CFP
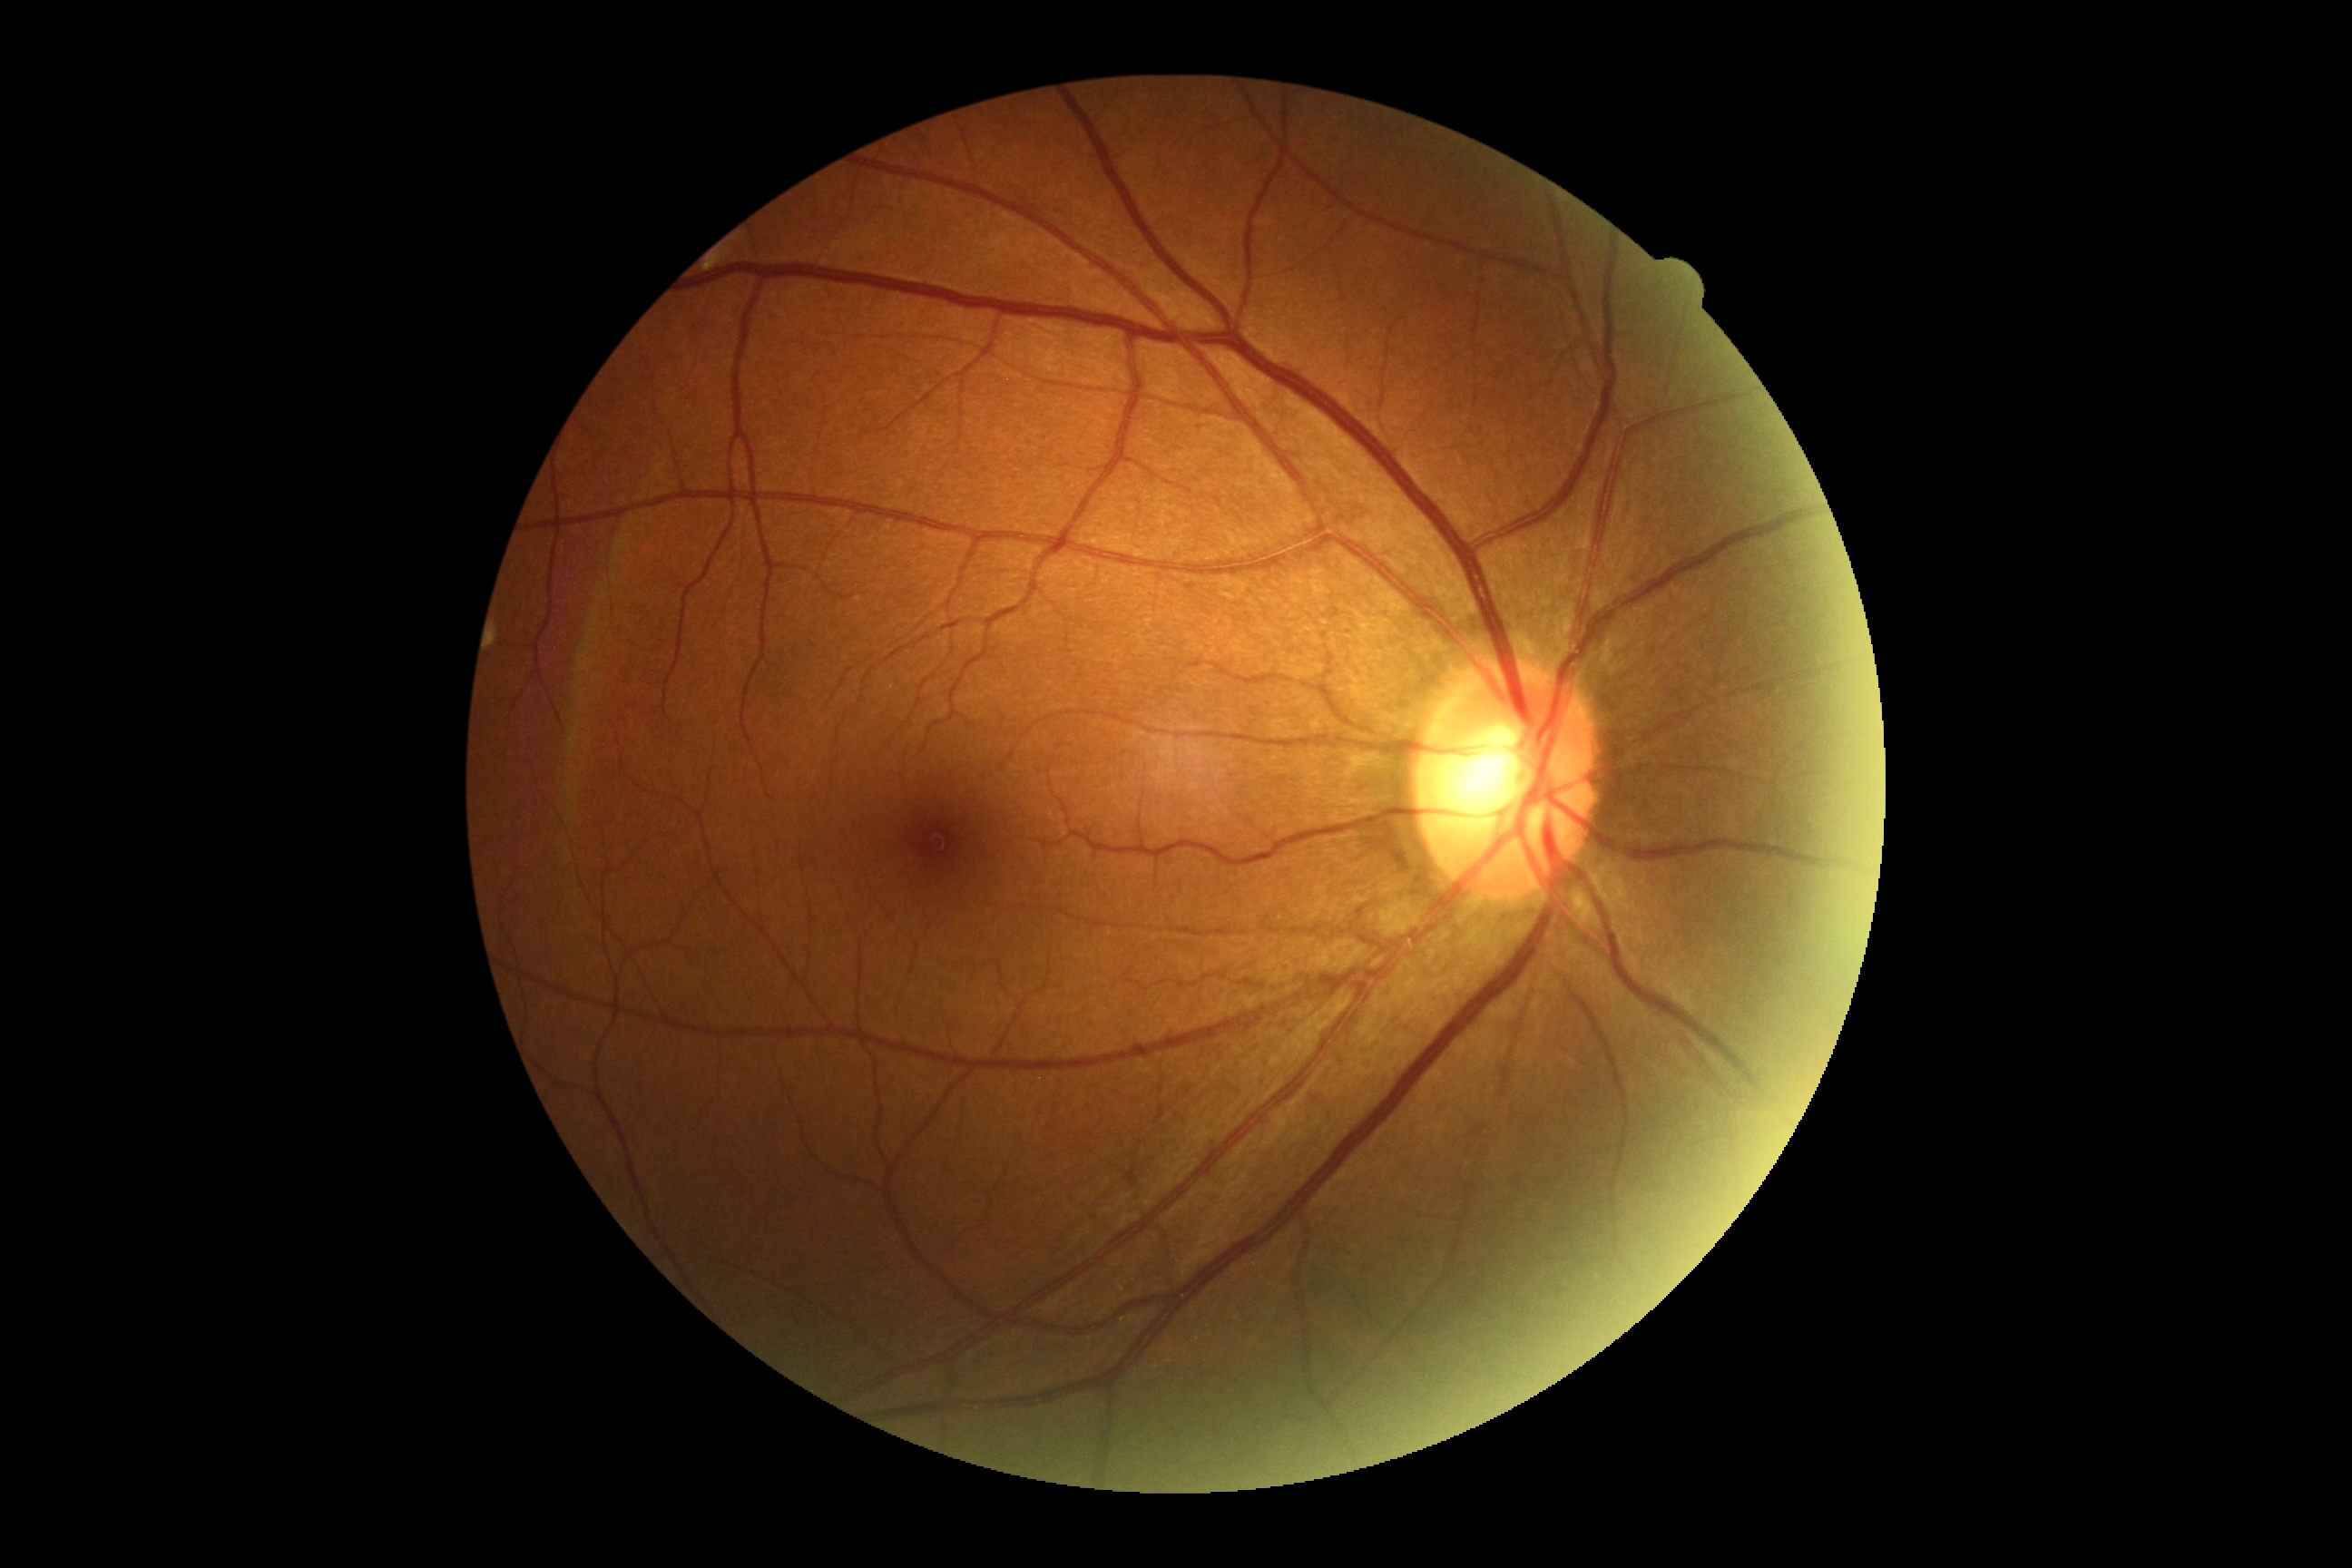
Diabetic retinopathy (DR) is grade 0.